45-degree field of view — 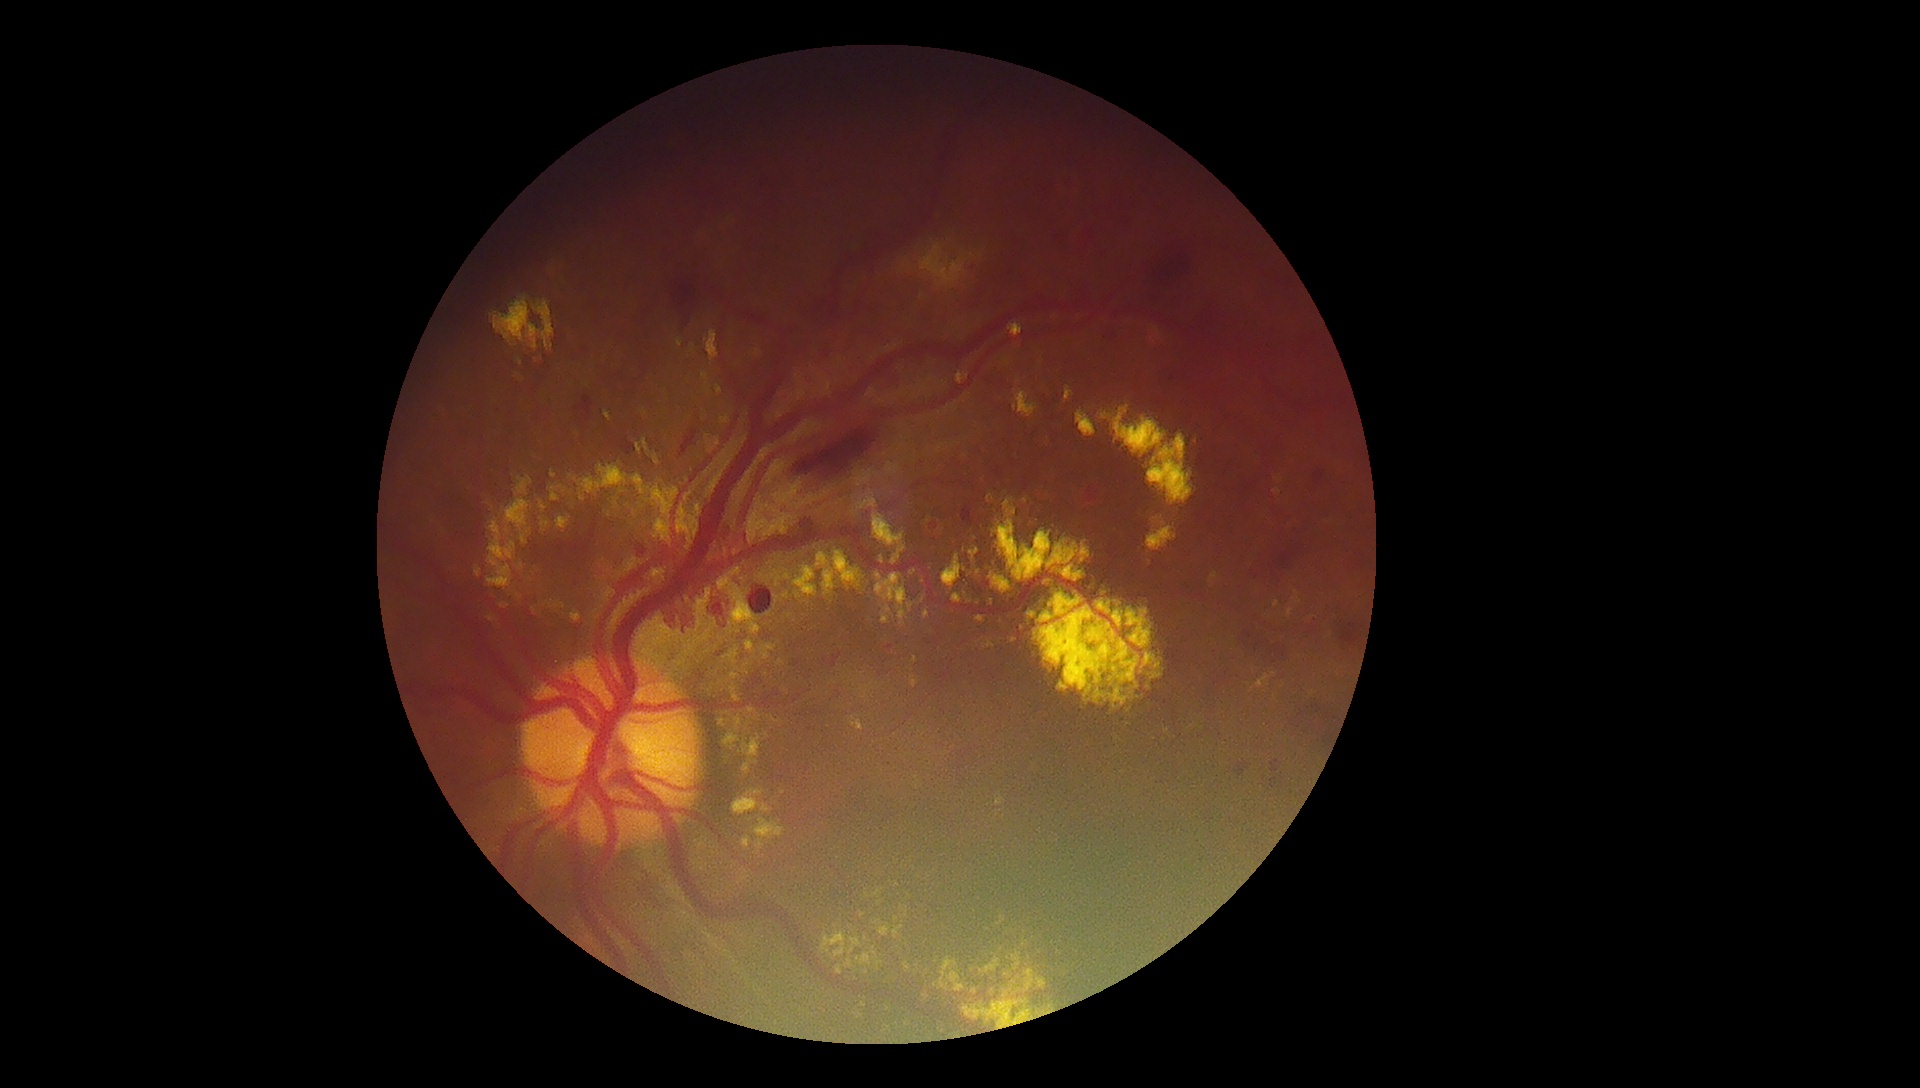

{"partial":true,"dr_grade":4,"lesions":{"ex":[[834,552,862,584],[632,475,646,495],[876,961,884,972],[875,573,907,627],[1292,591,1302,607],[955,939,1048,1025],[974,616,987,625],[696,589,712,618],[849,938,861,956],[707,386,712,396],[719,720,726,728],[521,535,528,545]],"ex_small":[[1018,382],[786,596],[577,434],[782,793],[570,476],[522,566],[915,659]]}}